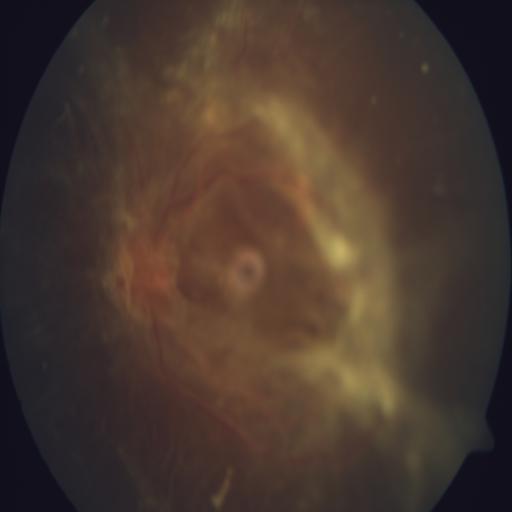 Abnormalities: retinal traction.